2048x1536px; fundus photo.
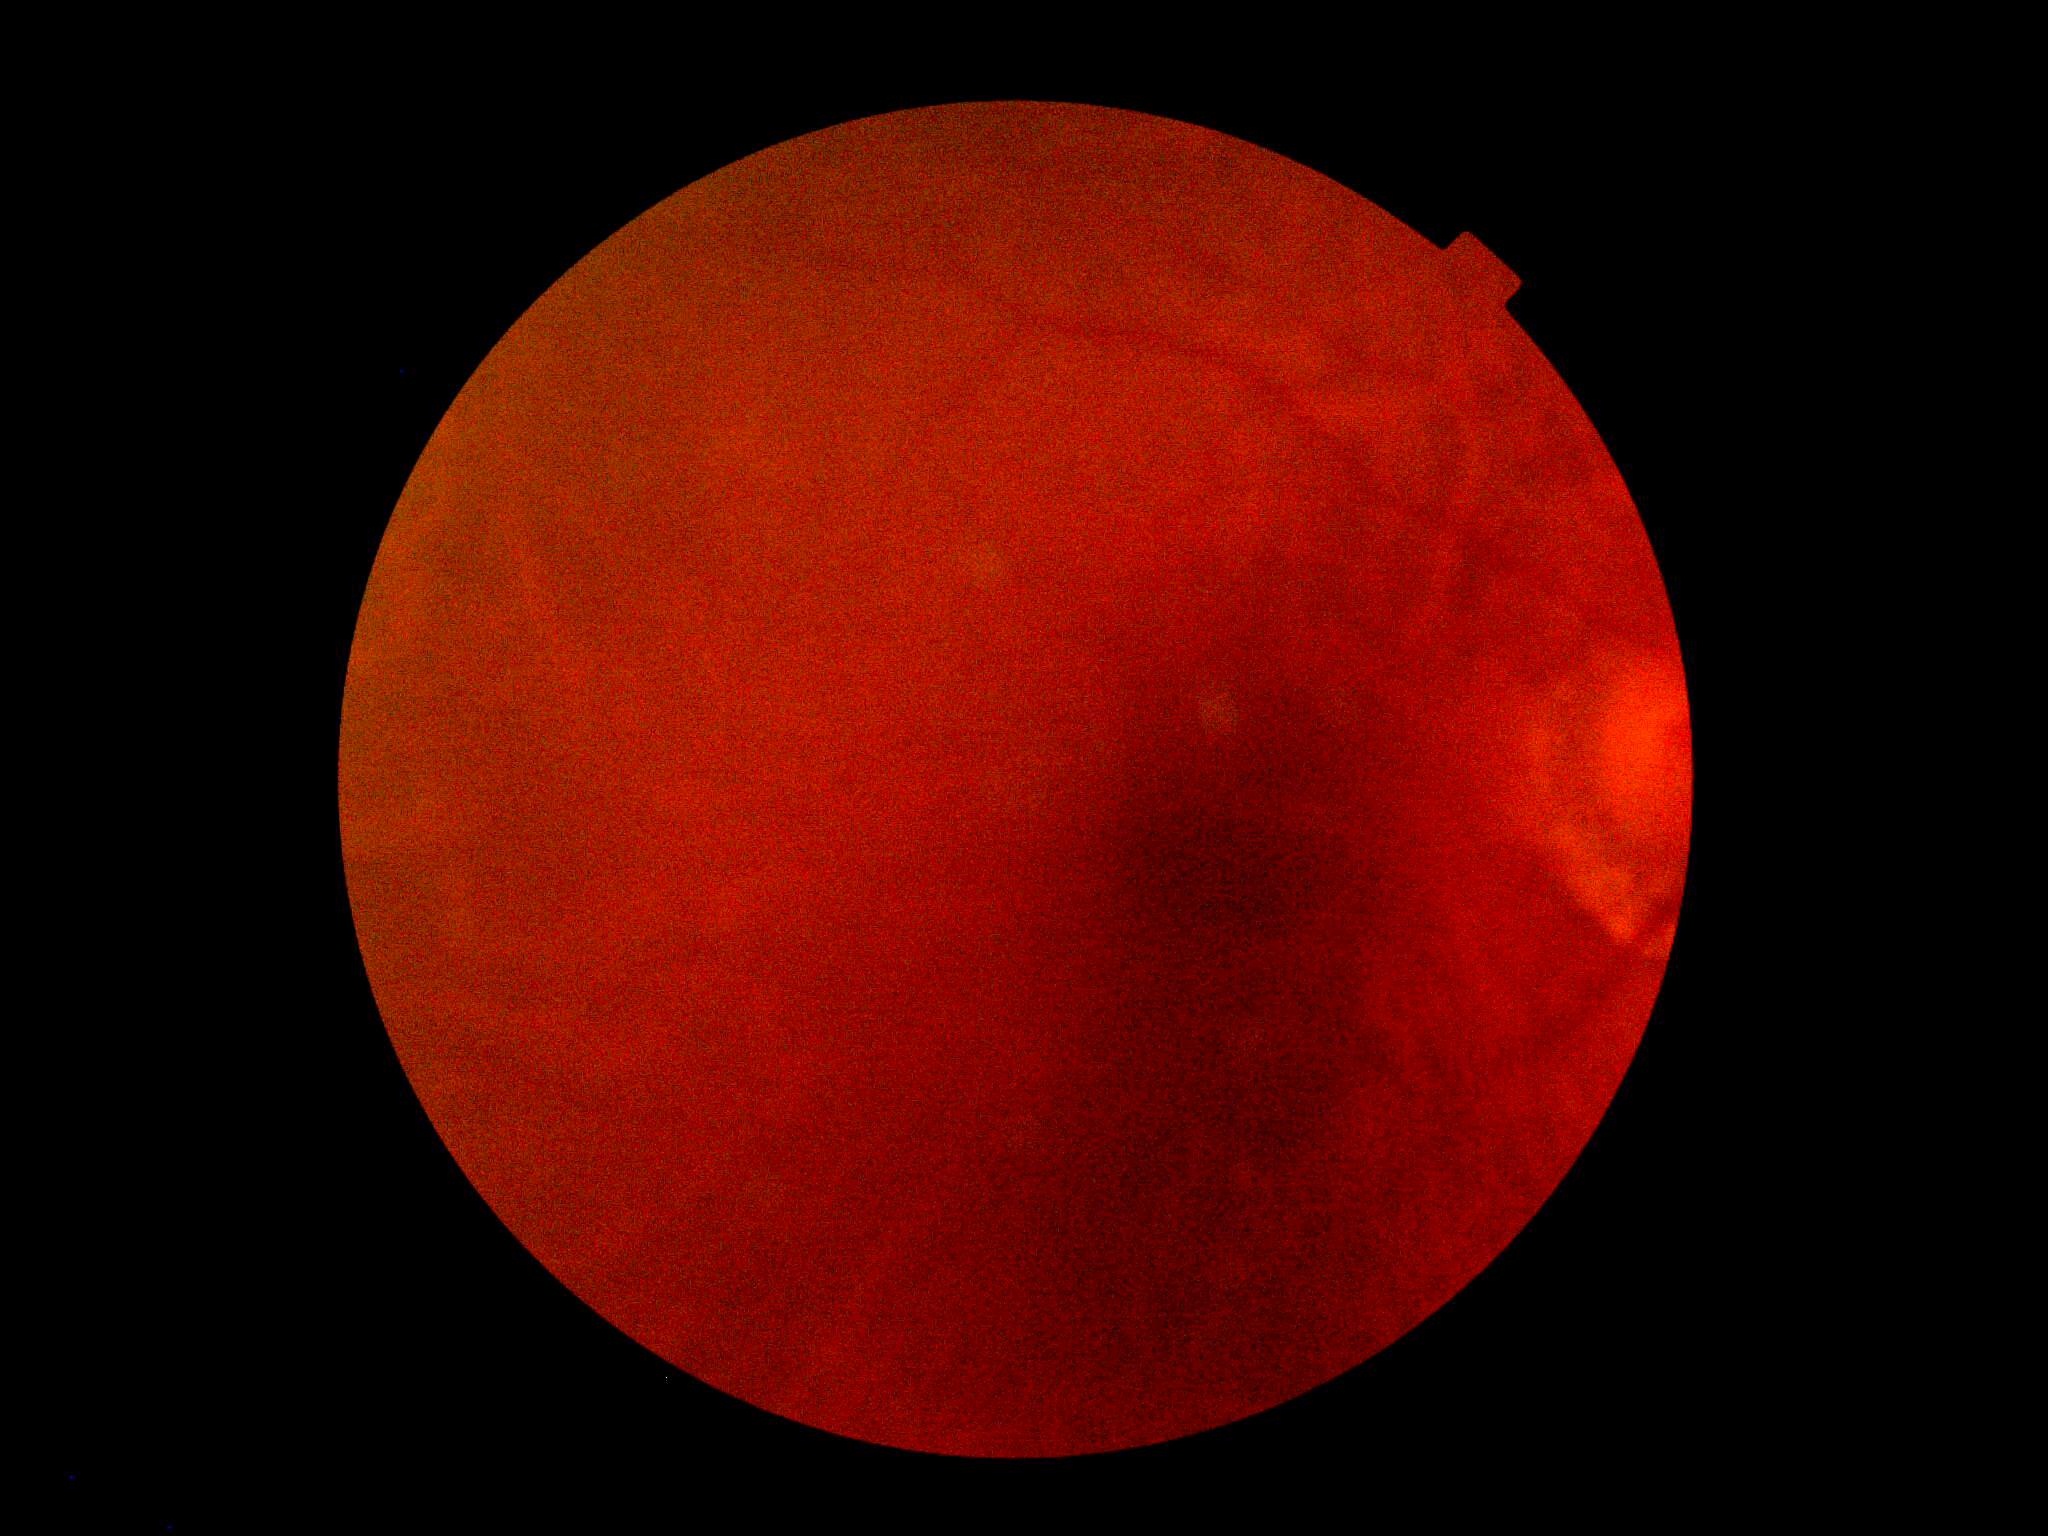
Diabetic retinopathy severity: ungradable. Image quality is insufficient for diabetic retinopathy assessment.